DR severity per modified Davis staging, 848x848px — 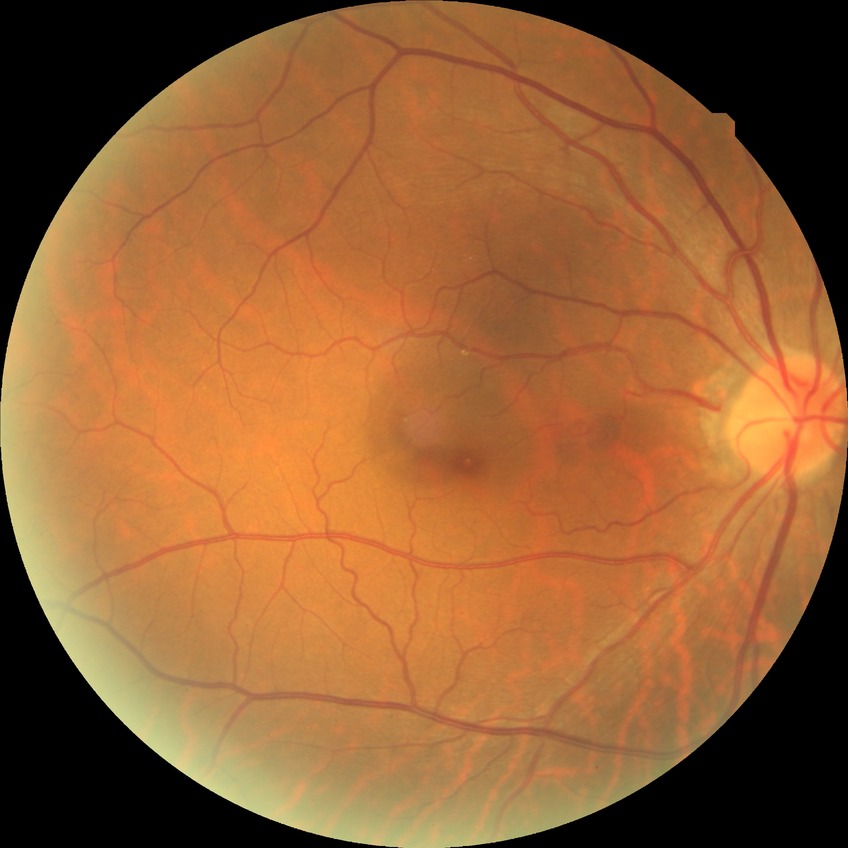

{"davis_grade": "no diabetic retinopathy (NDR)"}